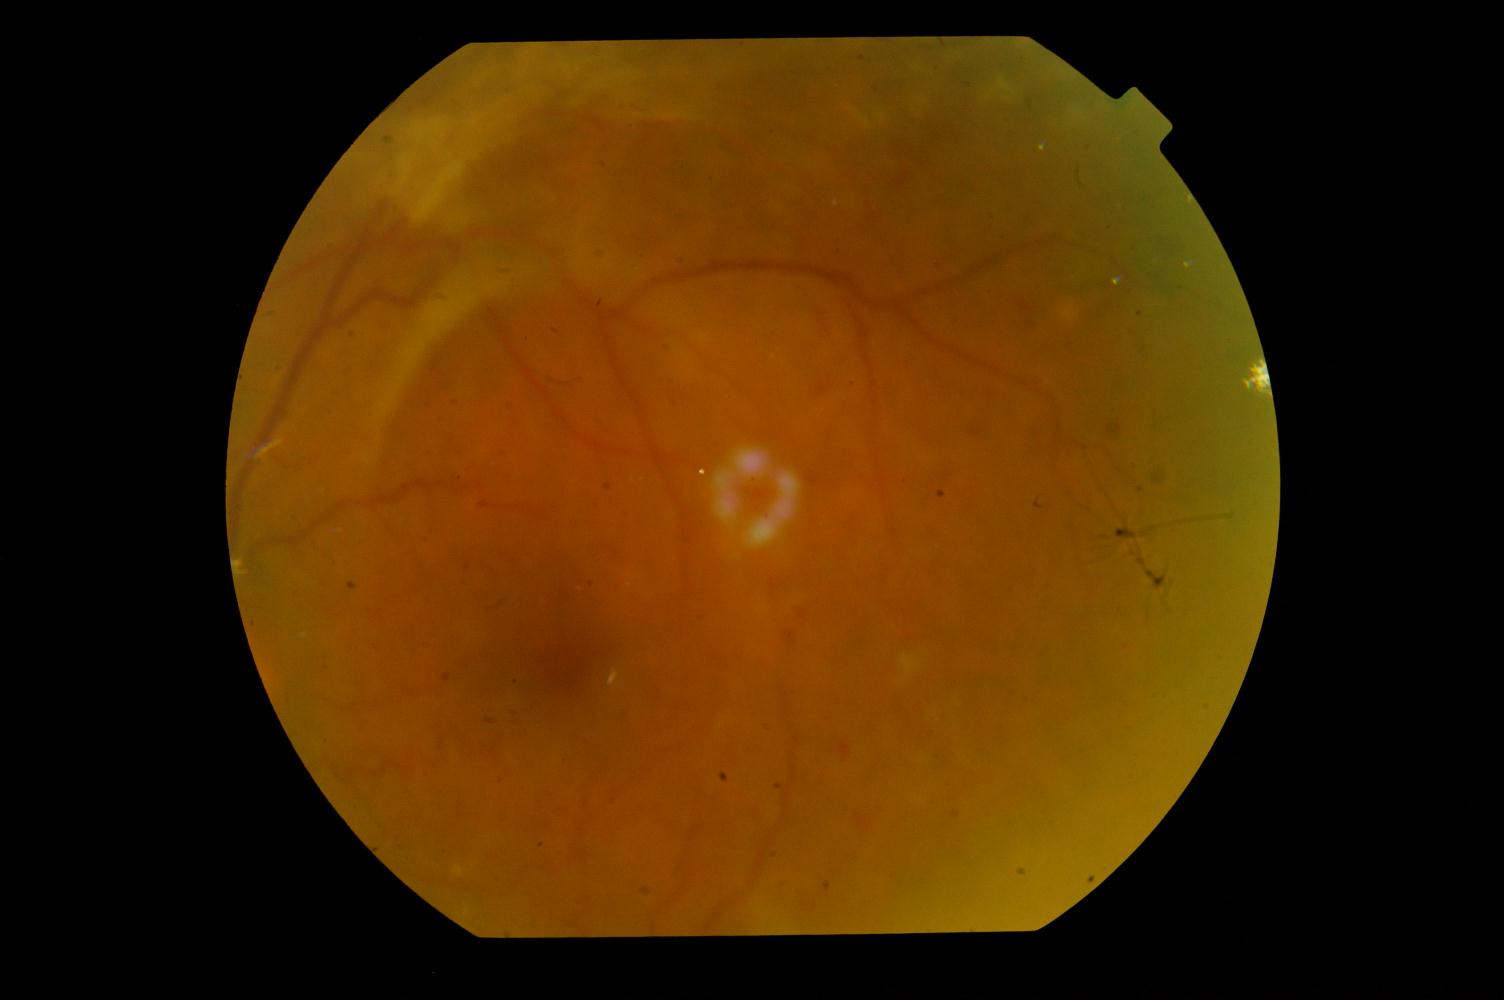
This fundus photograph shows diabetic retinopathy.